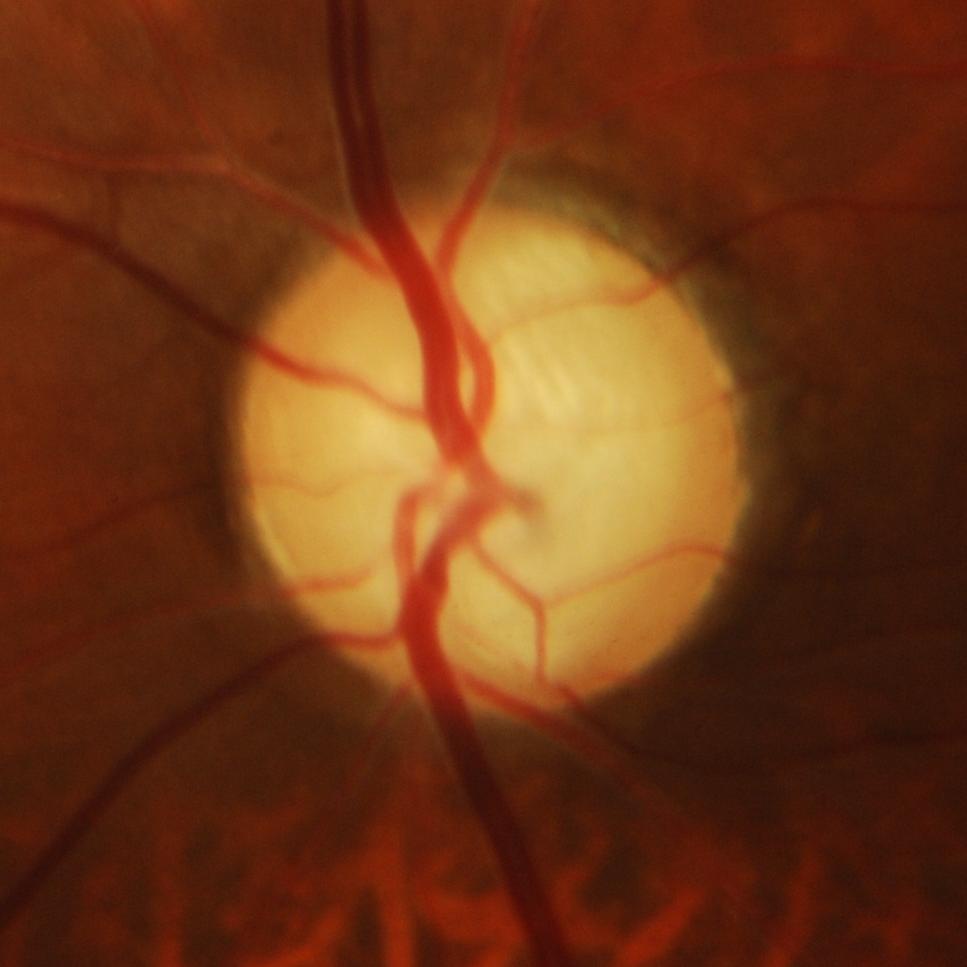 Glaucomatous changes.